Camera: Phoenix ICON (100° FOV). Phoenix ICON wide-field infant fundus image. Image size 1240x1240:
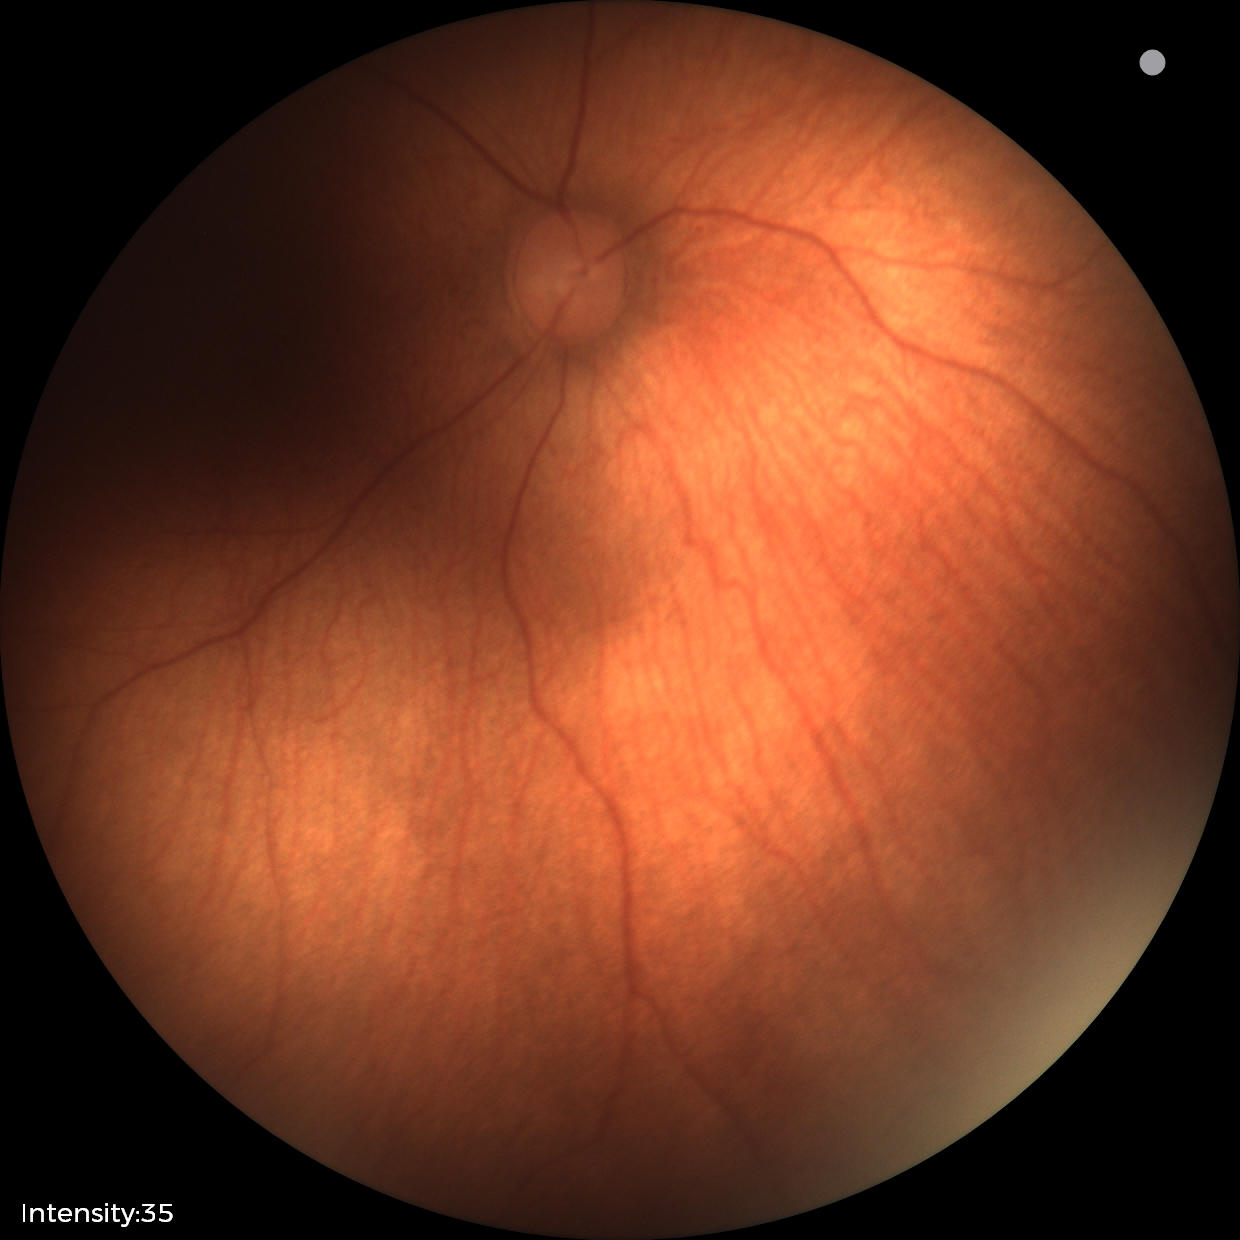 Screening examination with no abnormal retinal findings.